Wide-field contact fundus photograph of an infant
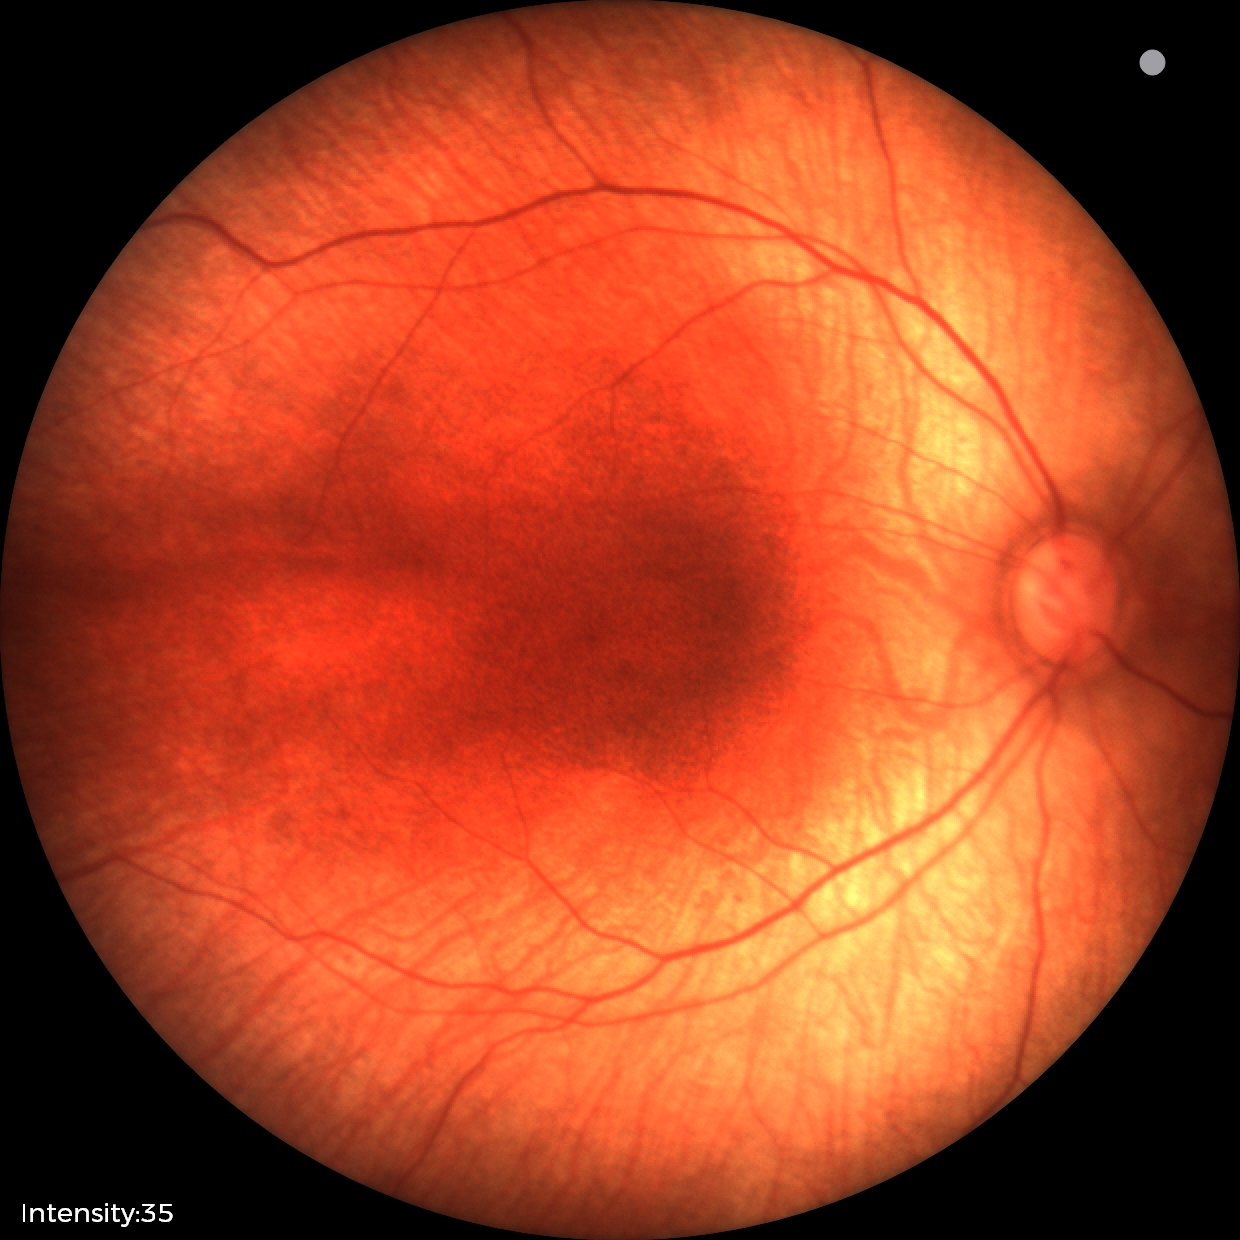
Screening examination with no abnormal retinal findings.